Wide-field contact fundus photograph of an infant — 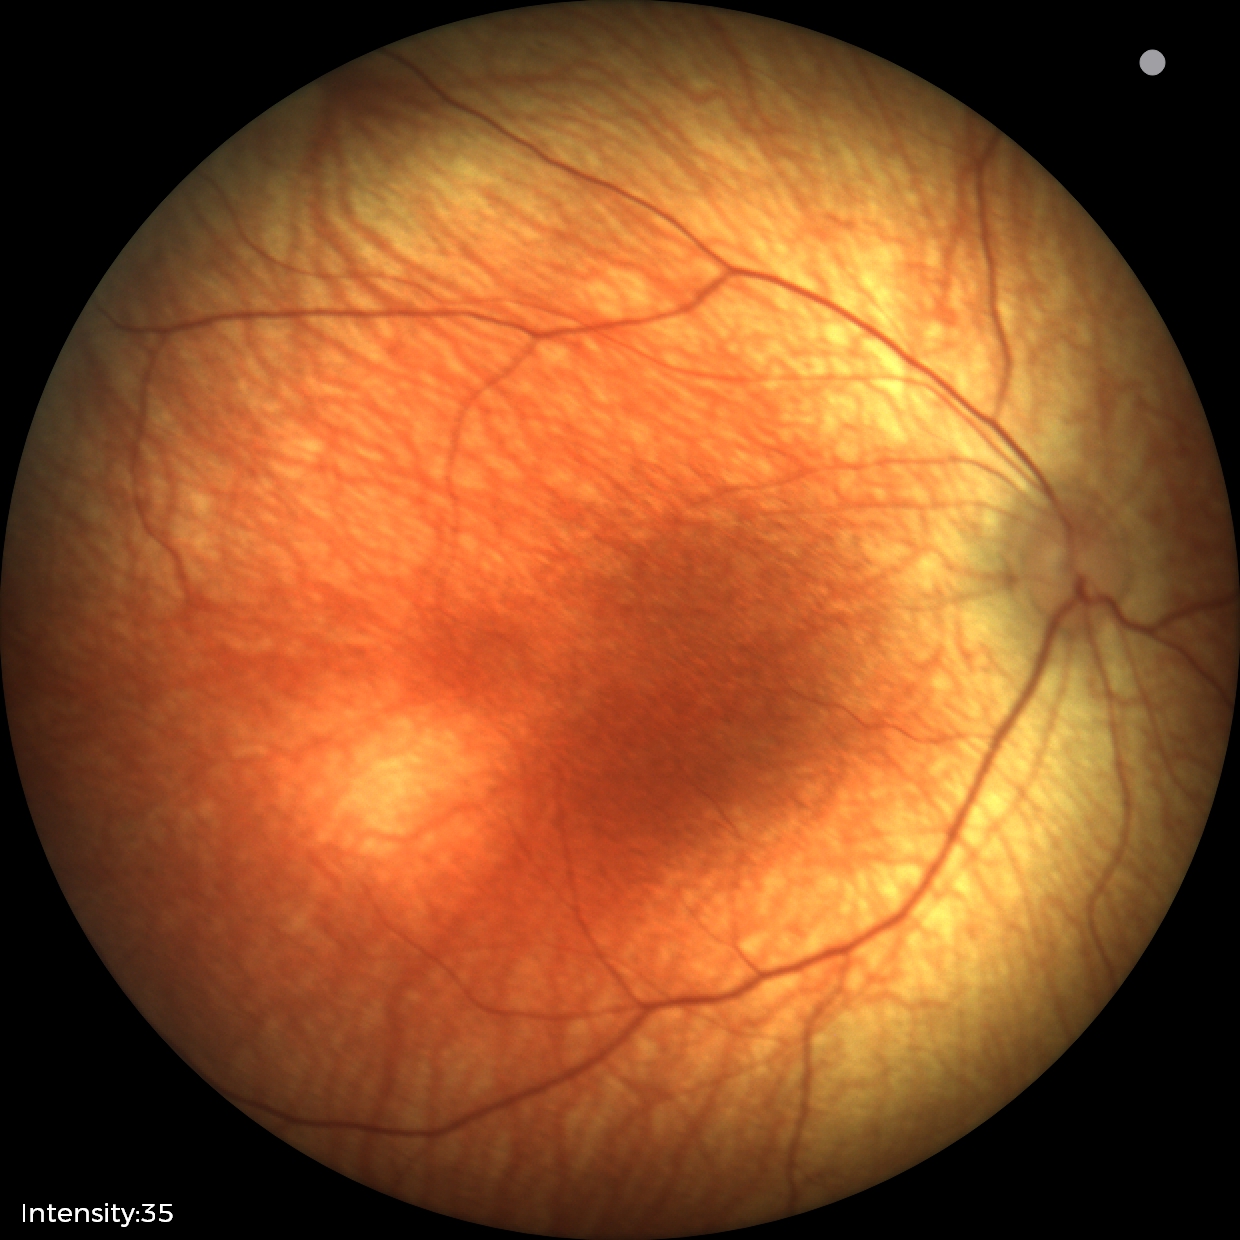 Physiological retinal appearance for postconceptual age.